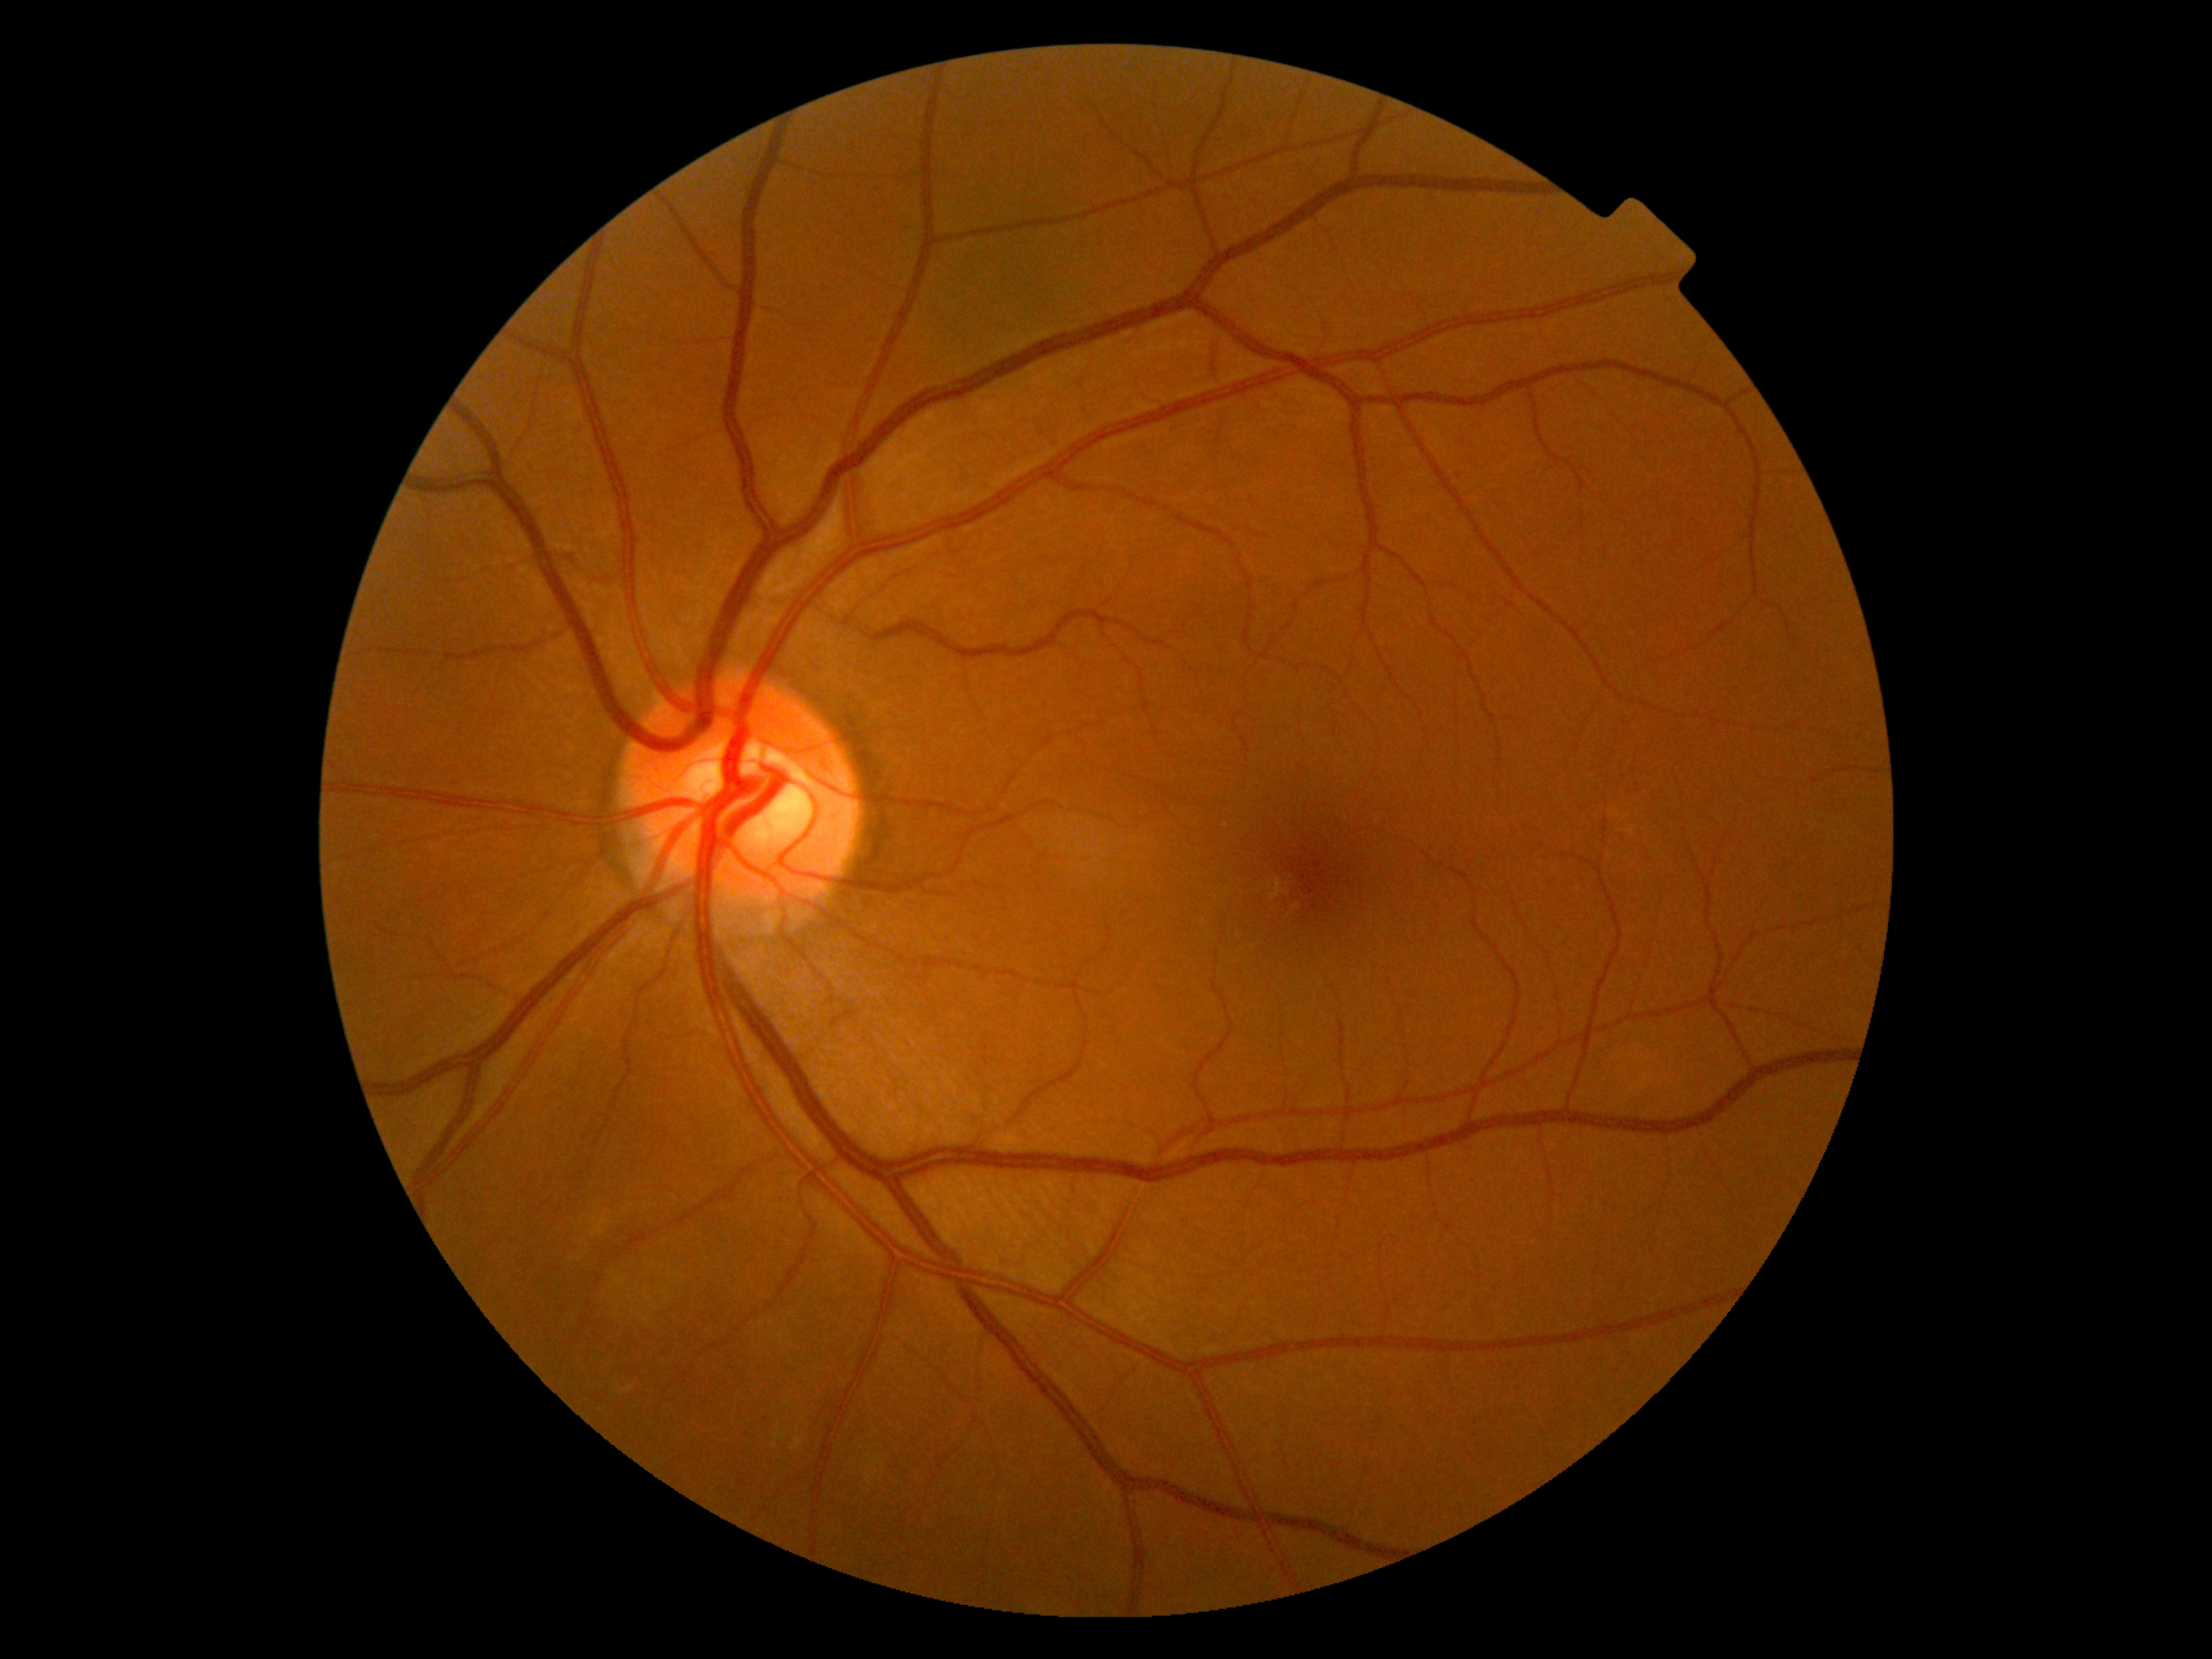
Diabetic retinopathy grade is 0. No apparent diabetic retinopathy.